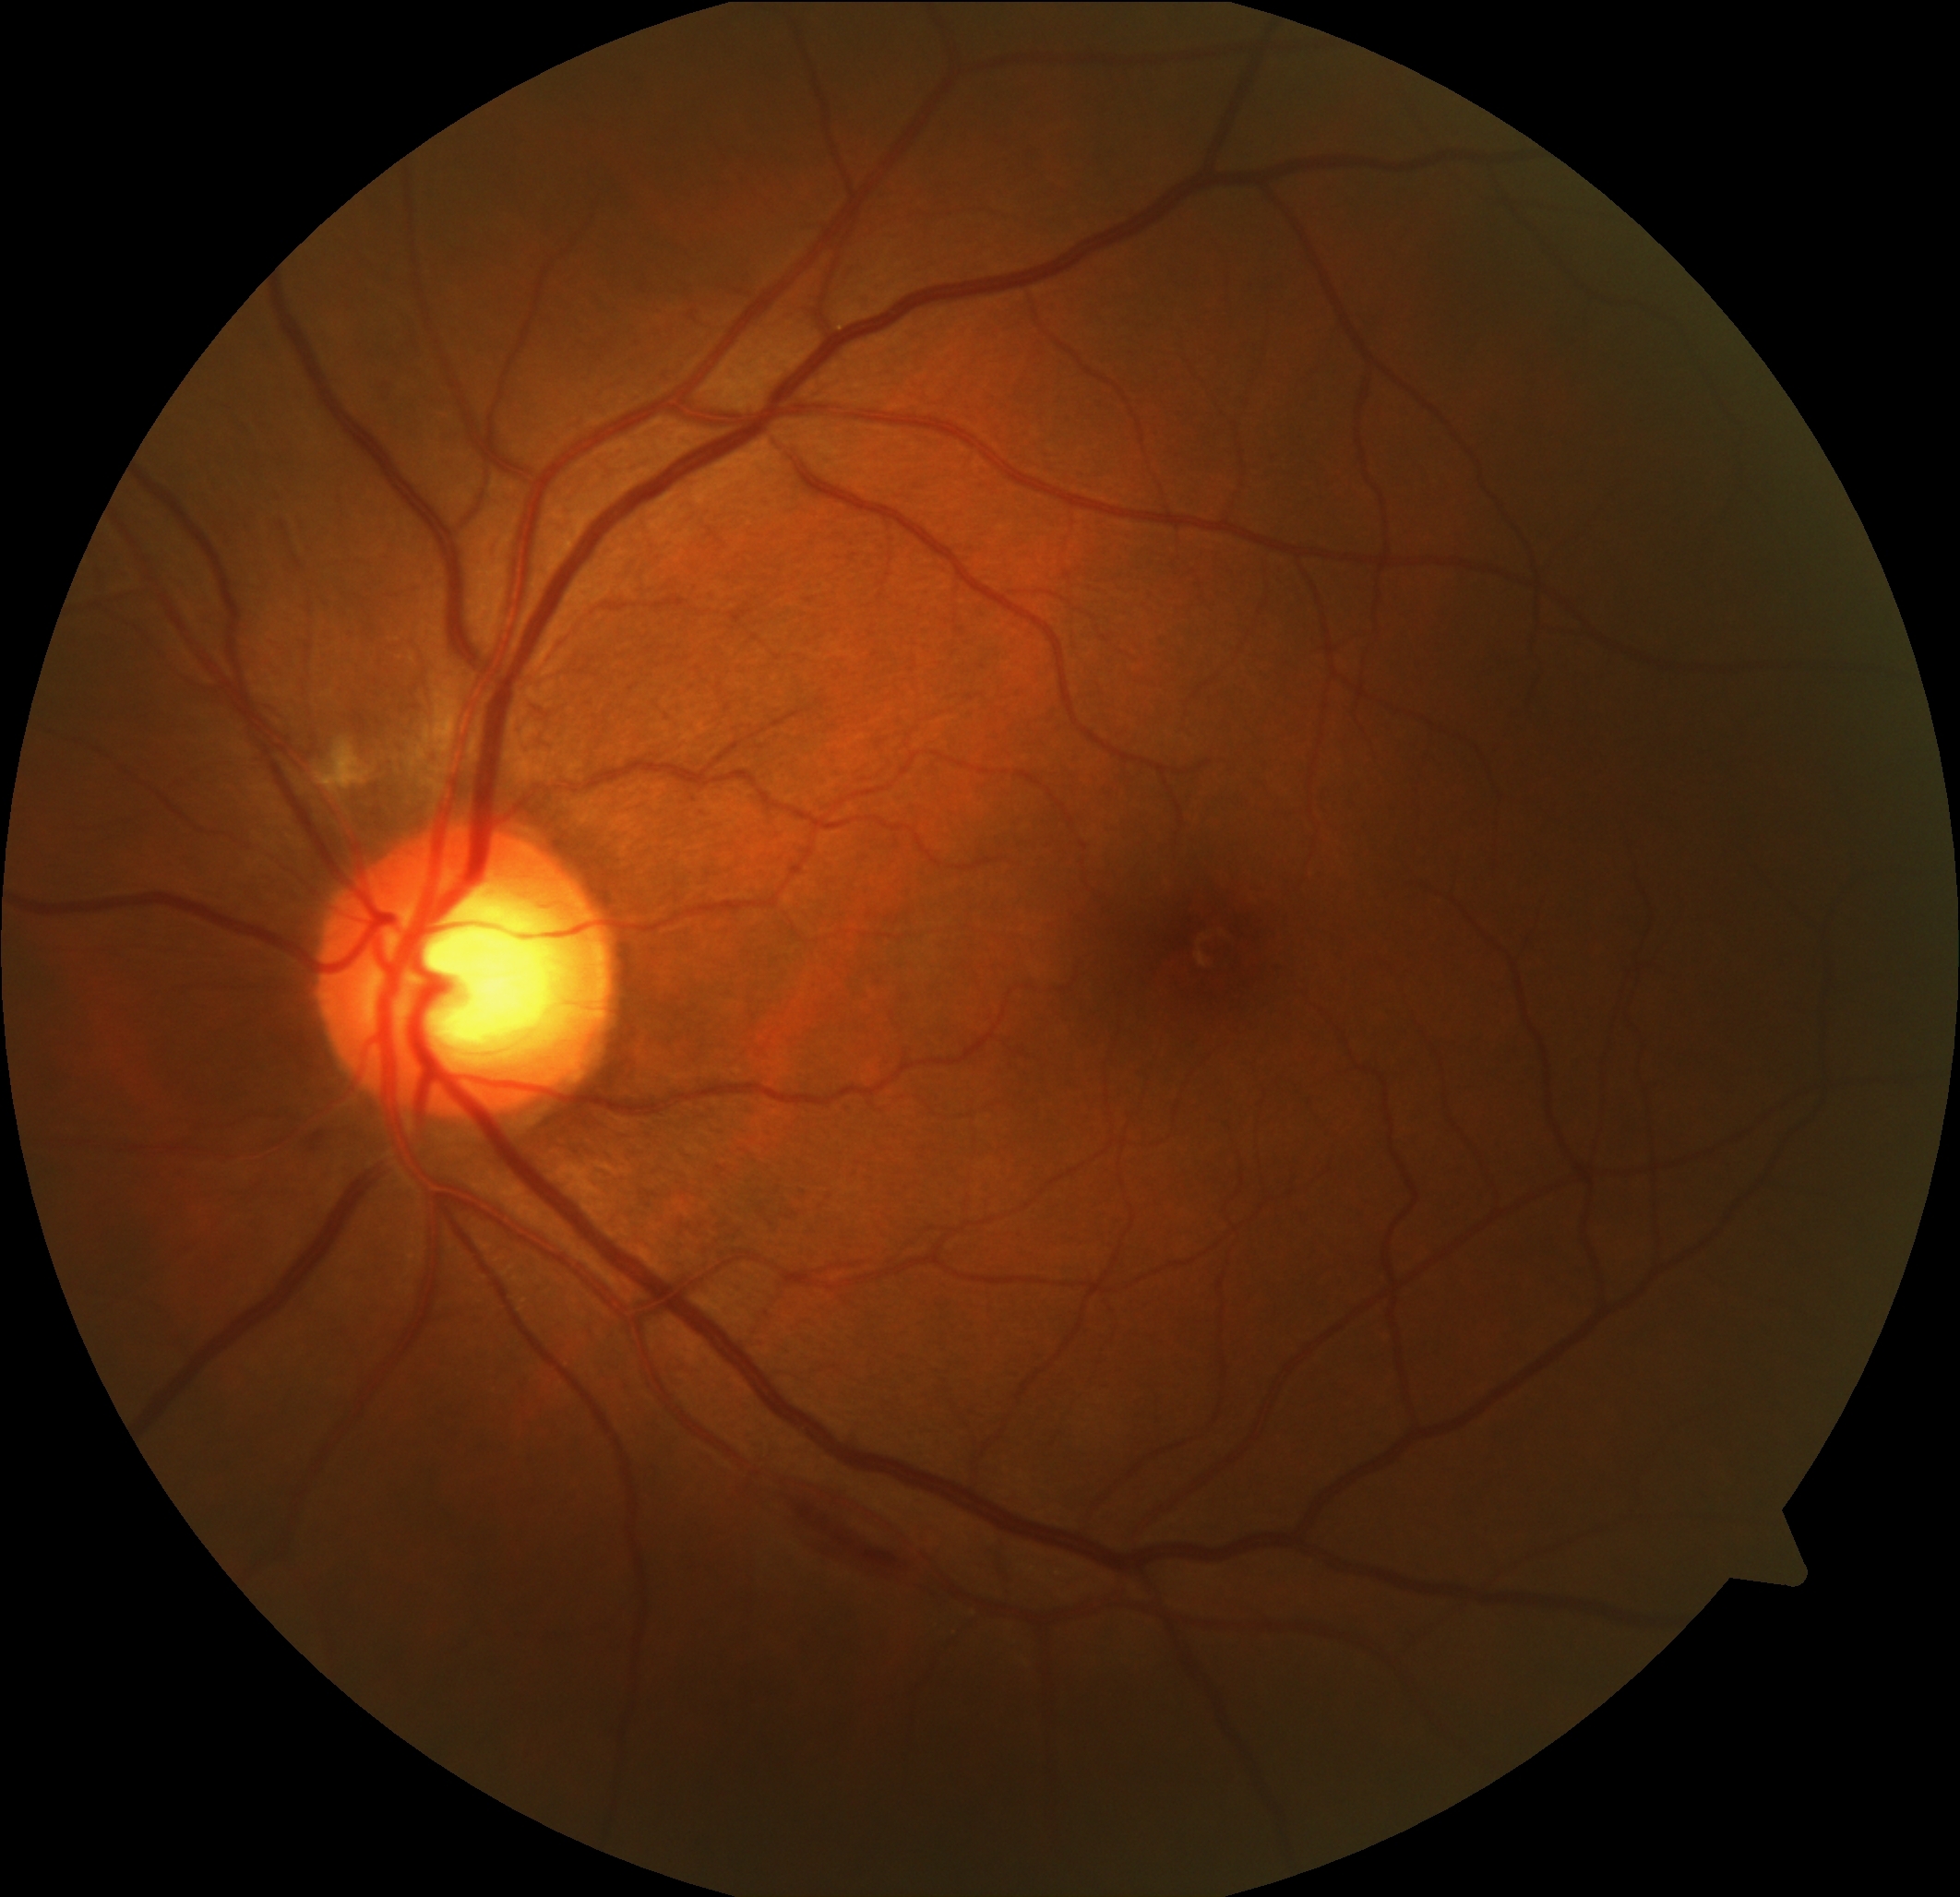

DR class = non-proliferative diabetic retinopathy
diabetic retinopathy (DR) = grade 2 (moderate NPDR)